FOV: 45 degrees:
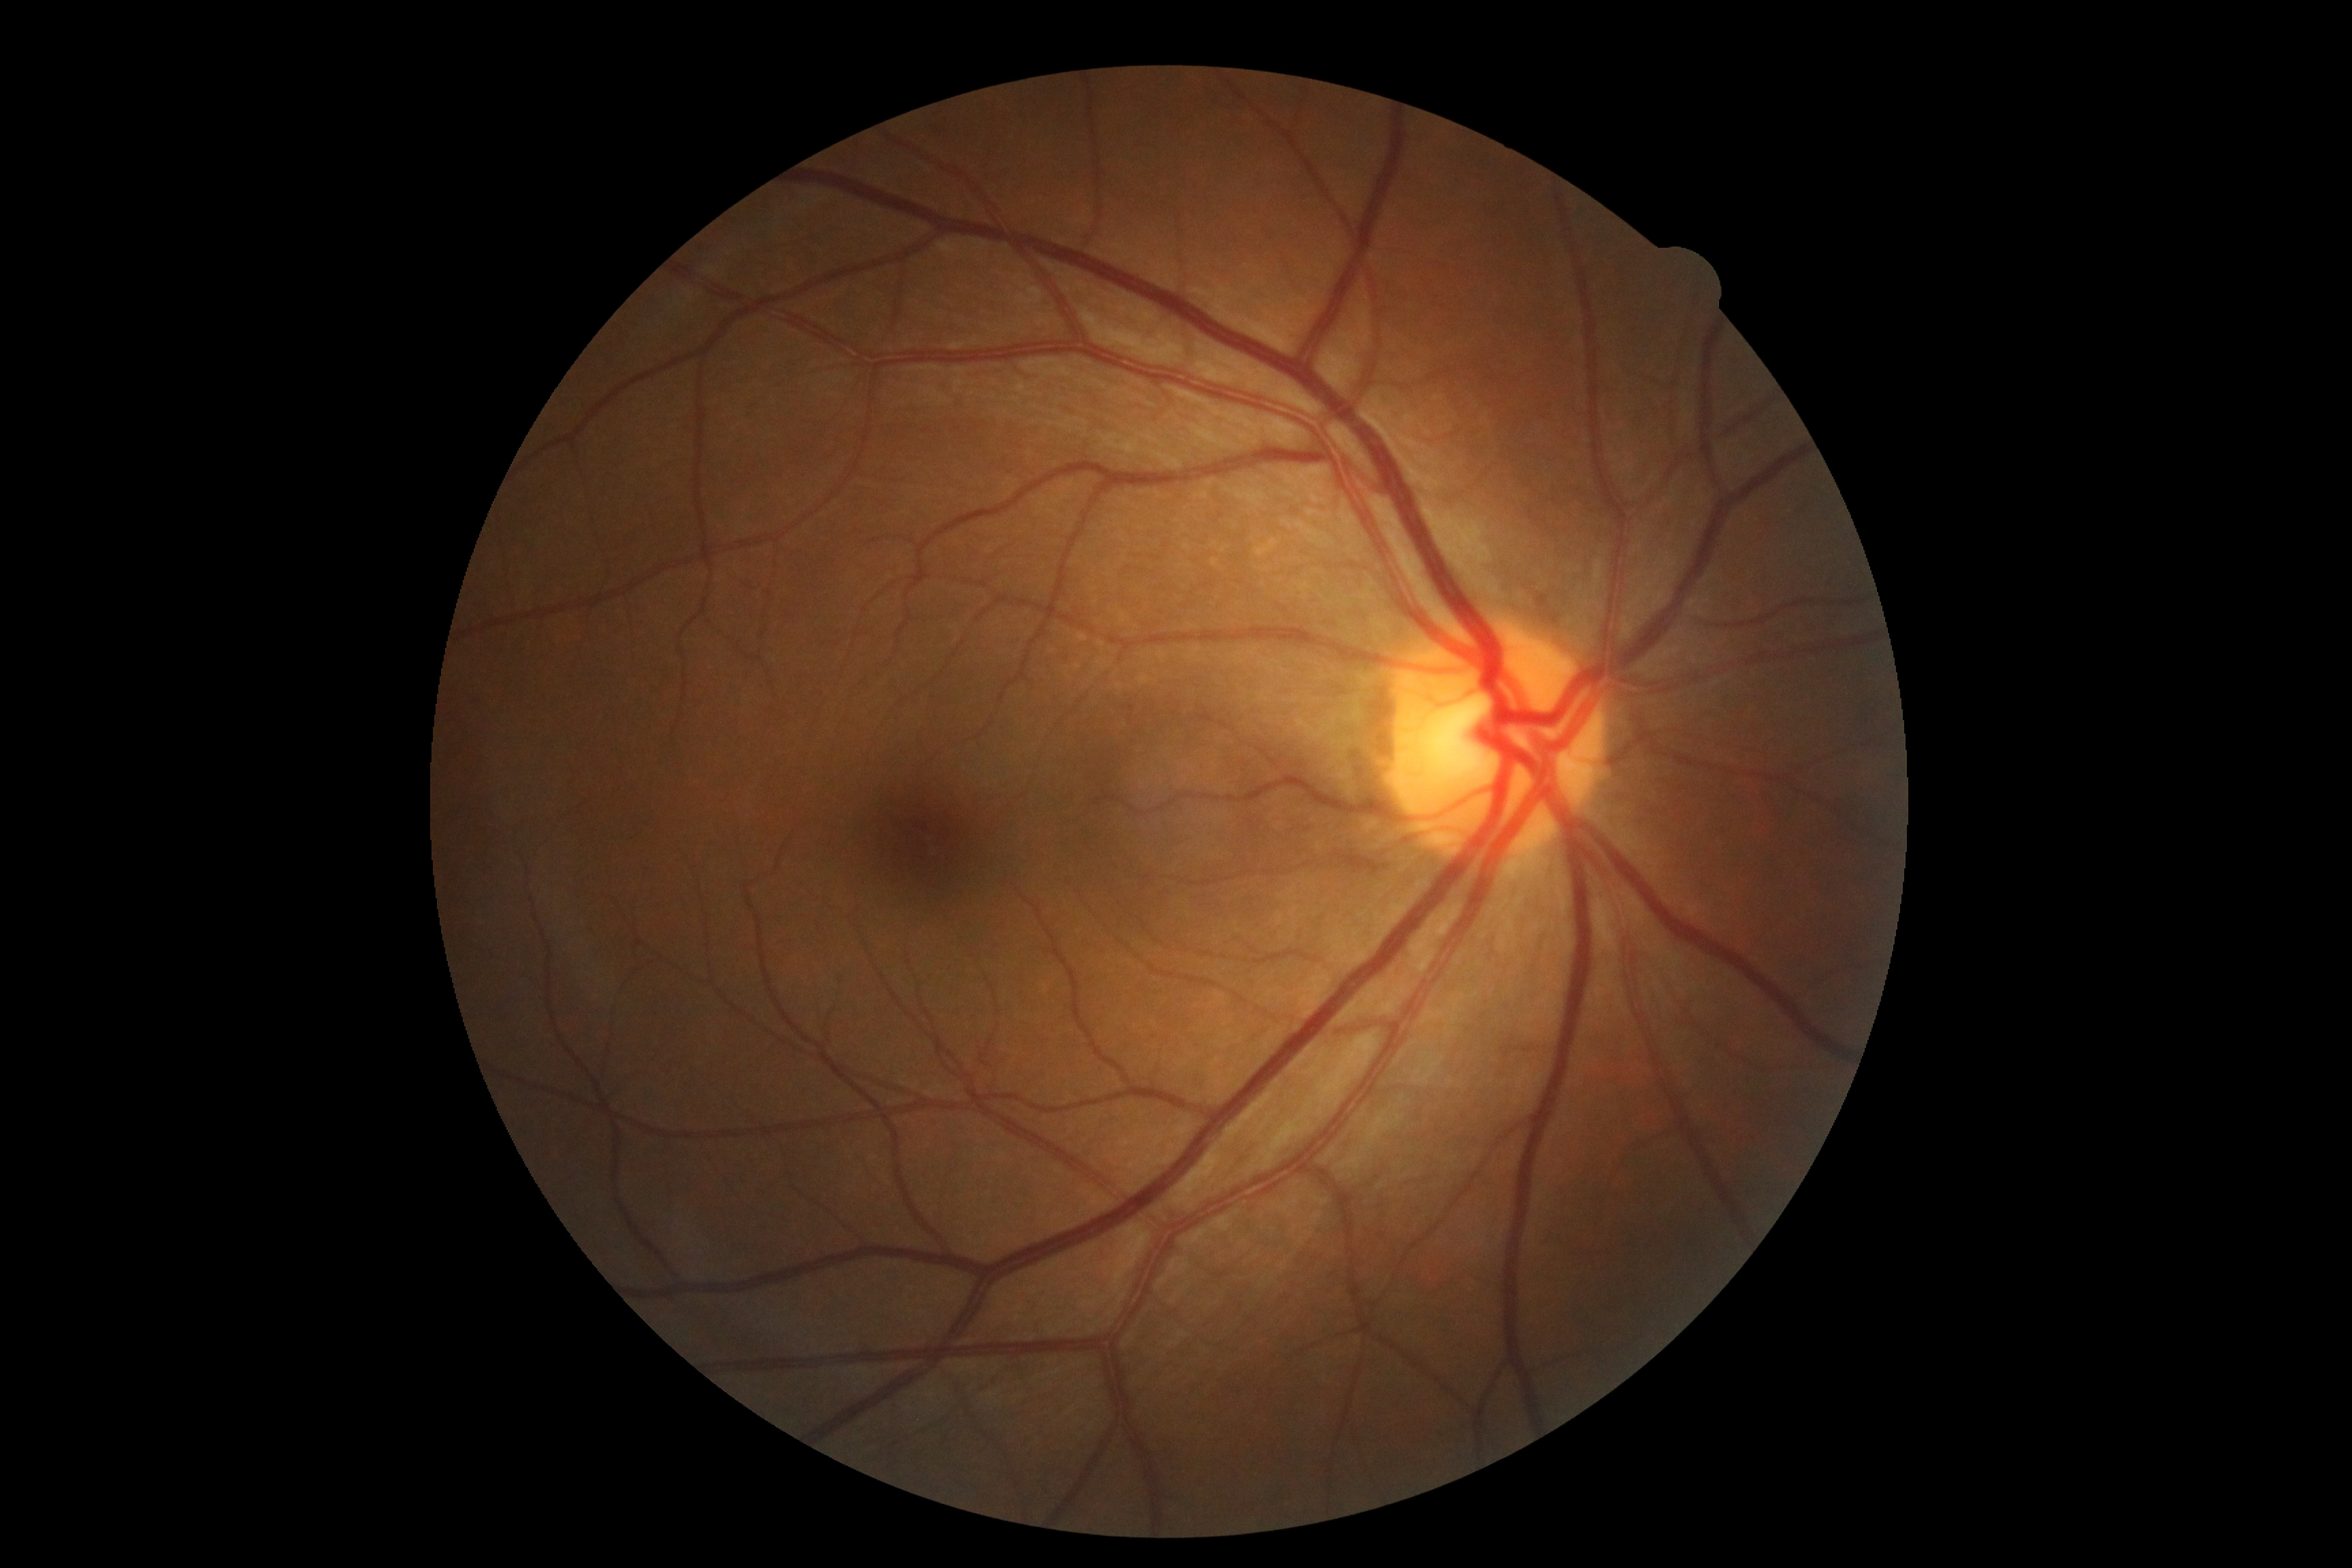

dr_impression: no apparent DR
dr_grade: no apparent diabetic retinopathy (0)